100° field of view (Phoenix ICON) · pediatric wide-field fundus photograph.
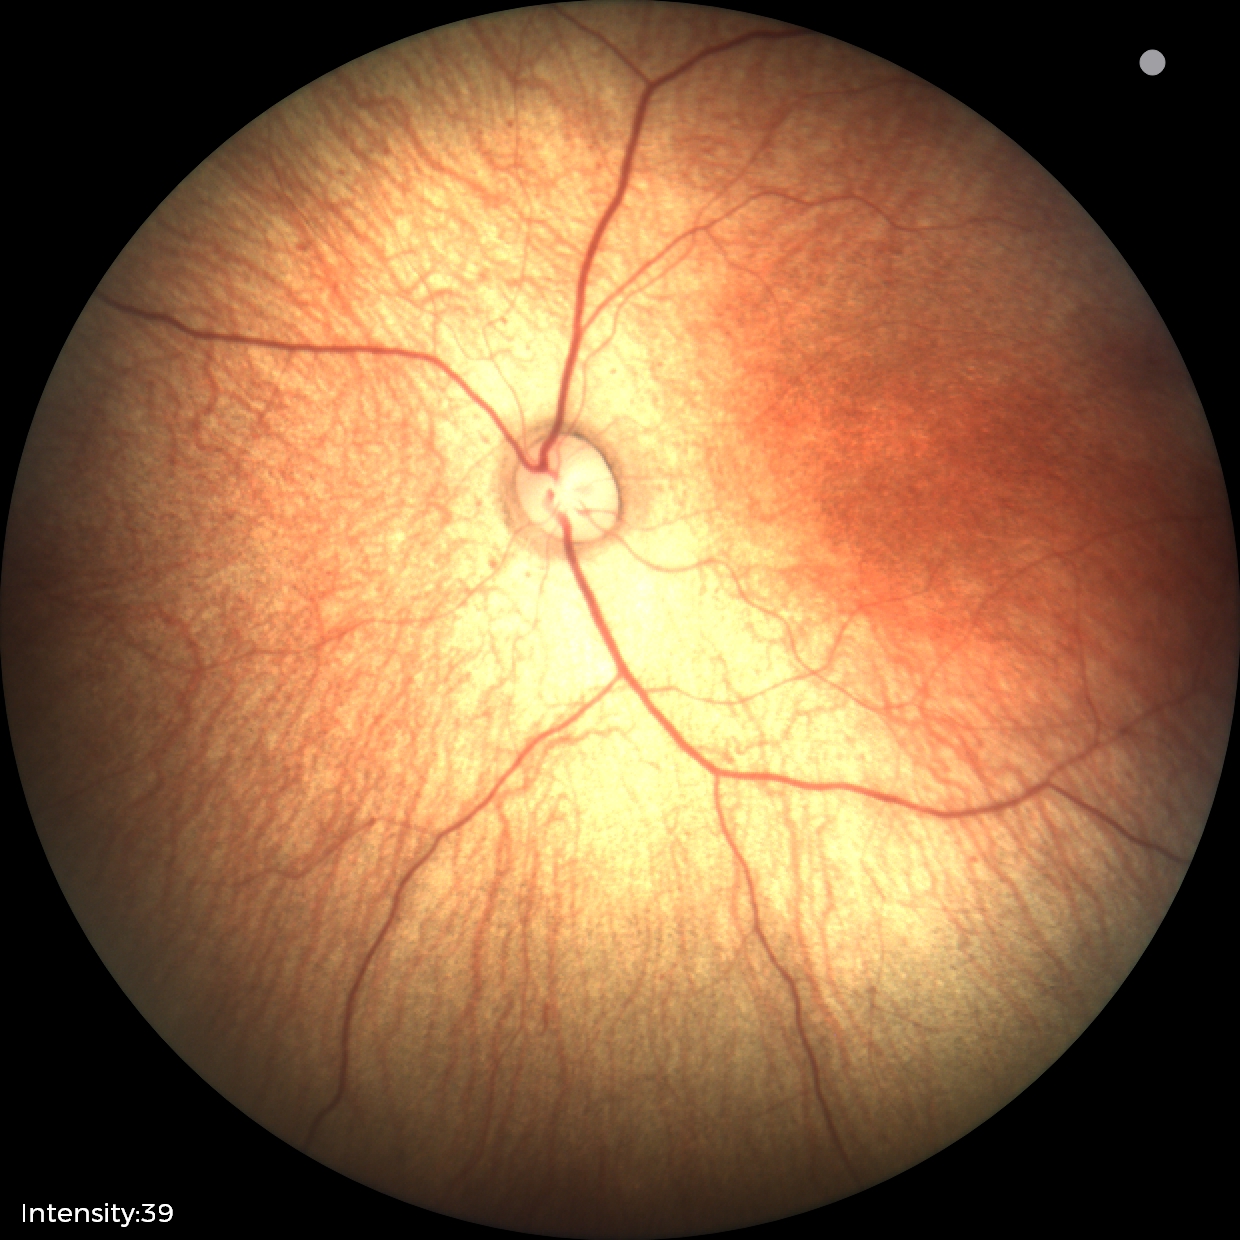

Physiological retinal appearance for postconceptual age.